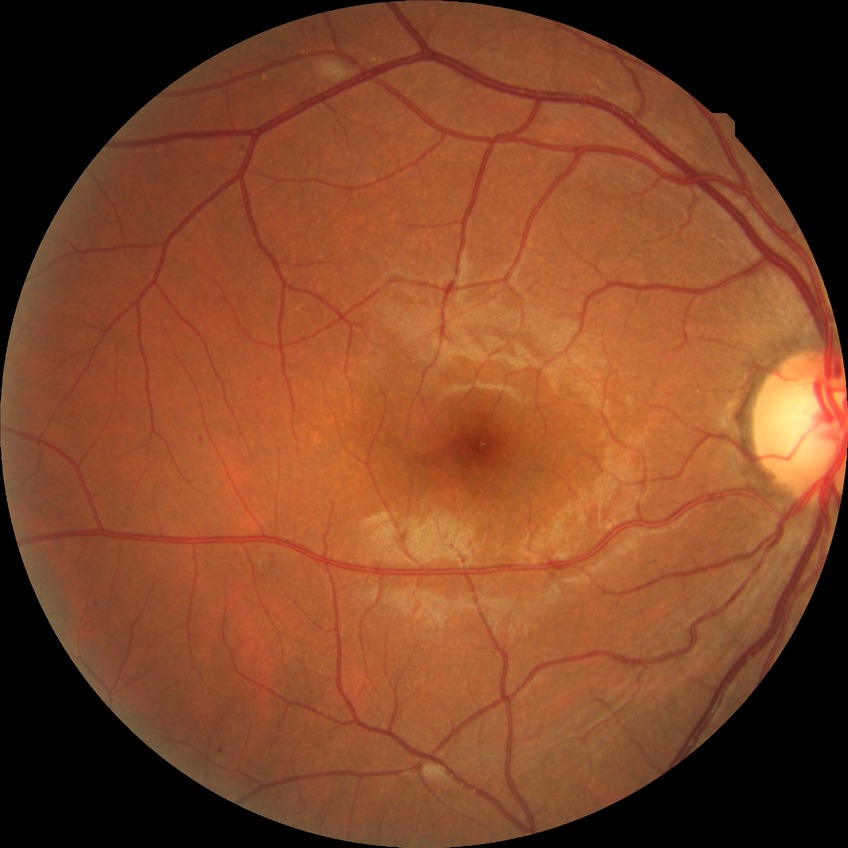 Diabetic retinopathy grade: simple diabetic retinopathy.